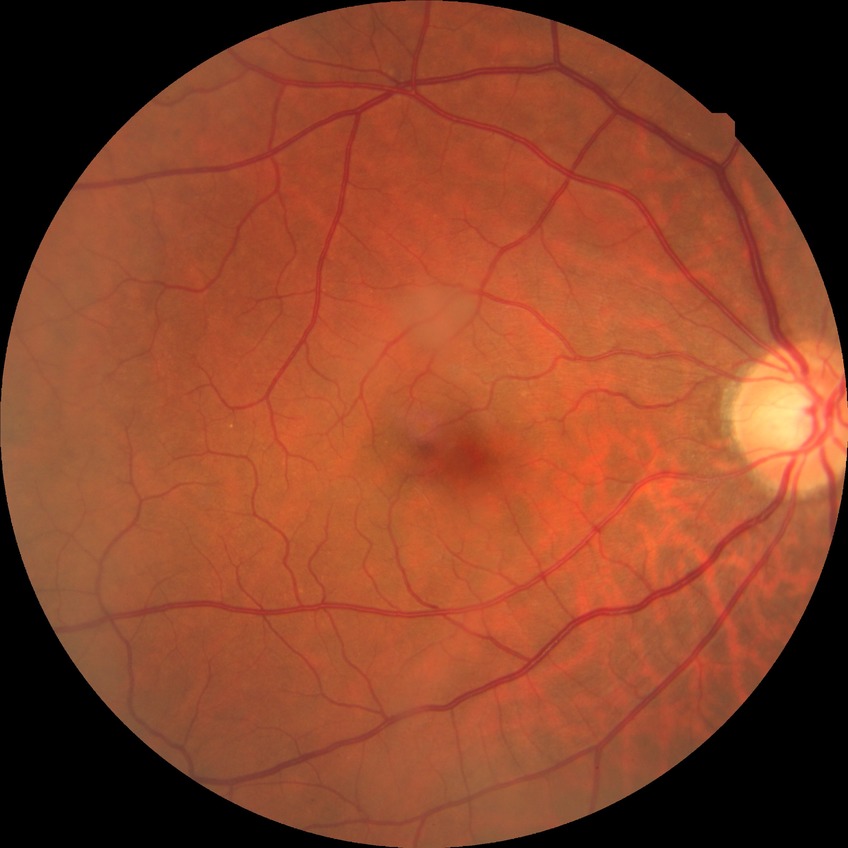

diabetic retinopathy (DR) = NDR (no diabetic retinopathy).